NIDEK AFC-230 fundus camera — 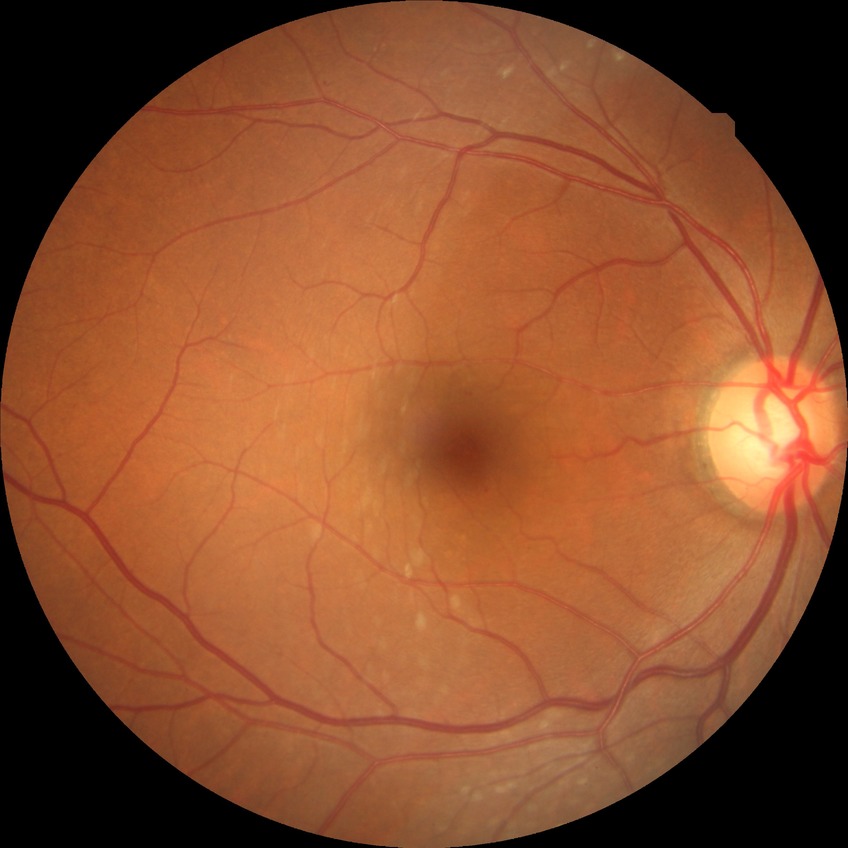
  davis_grade: no diabetic retinopathy